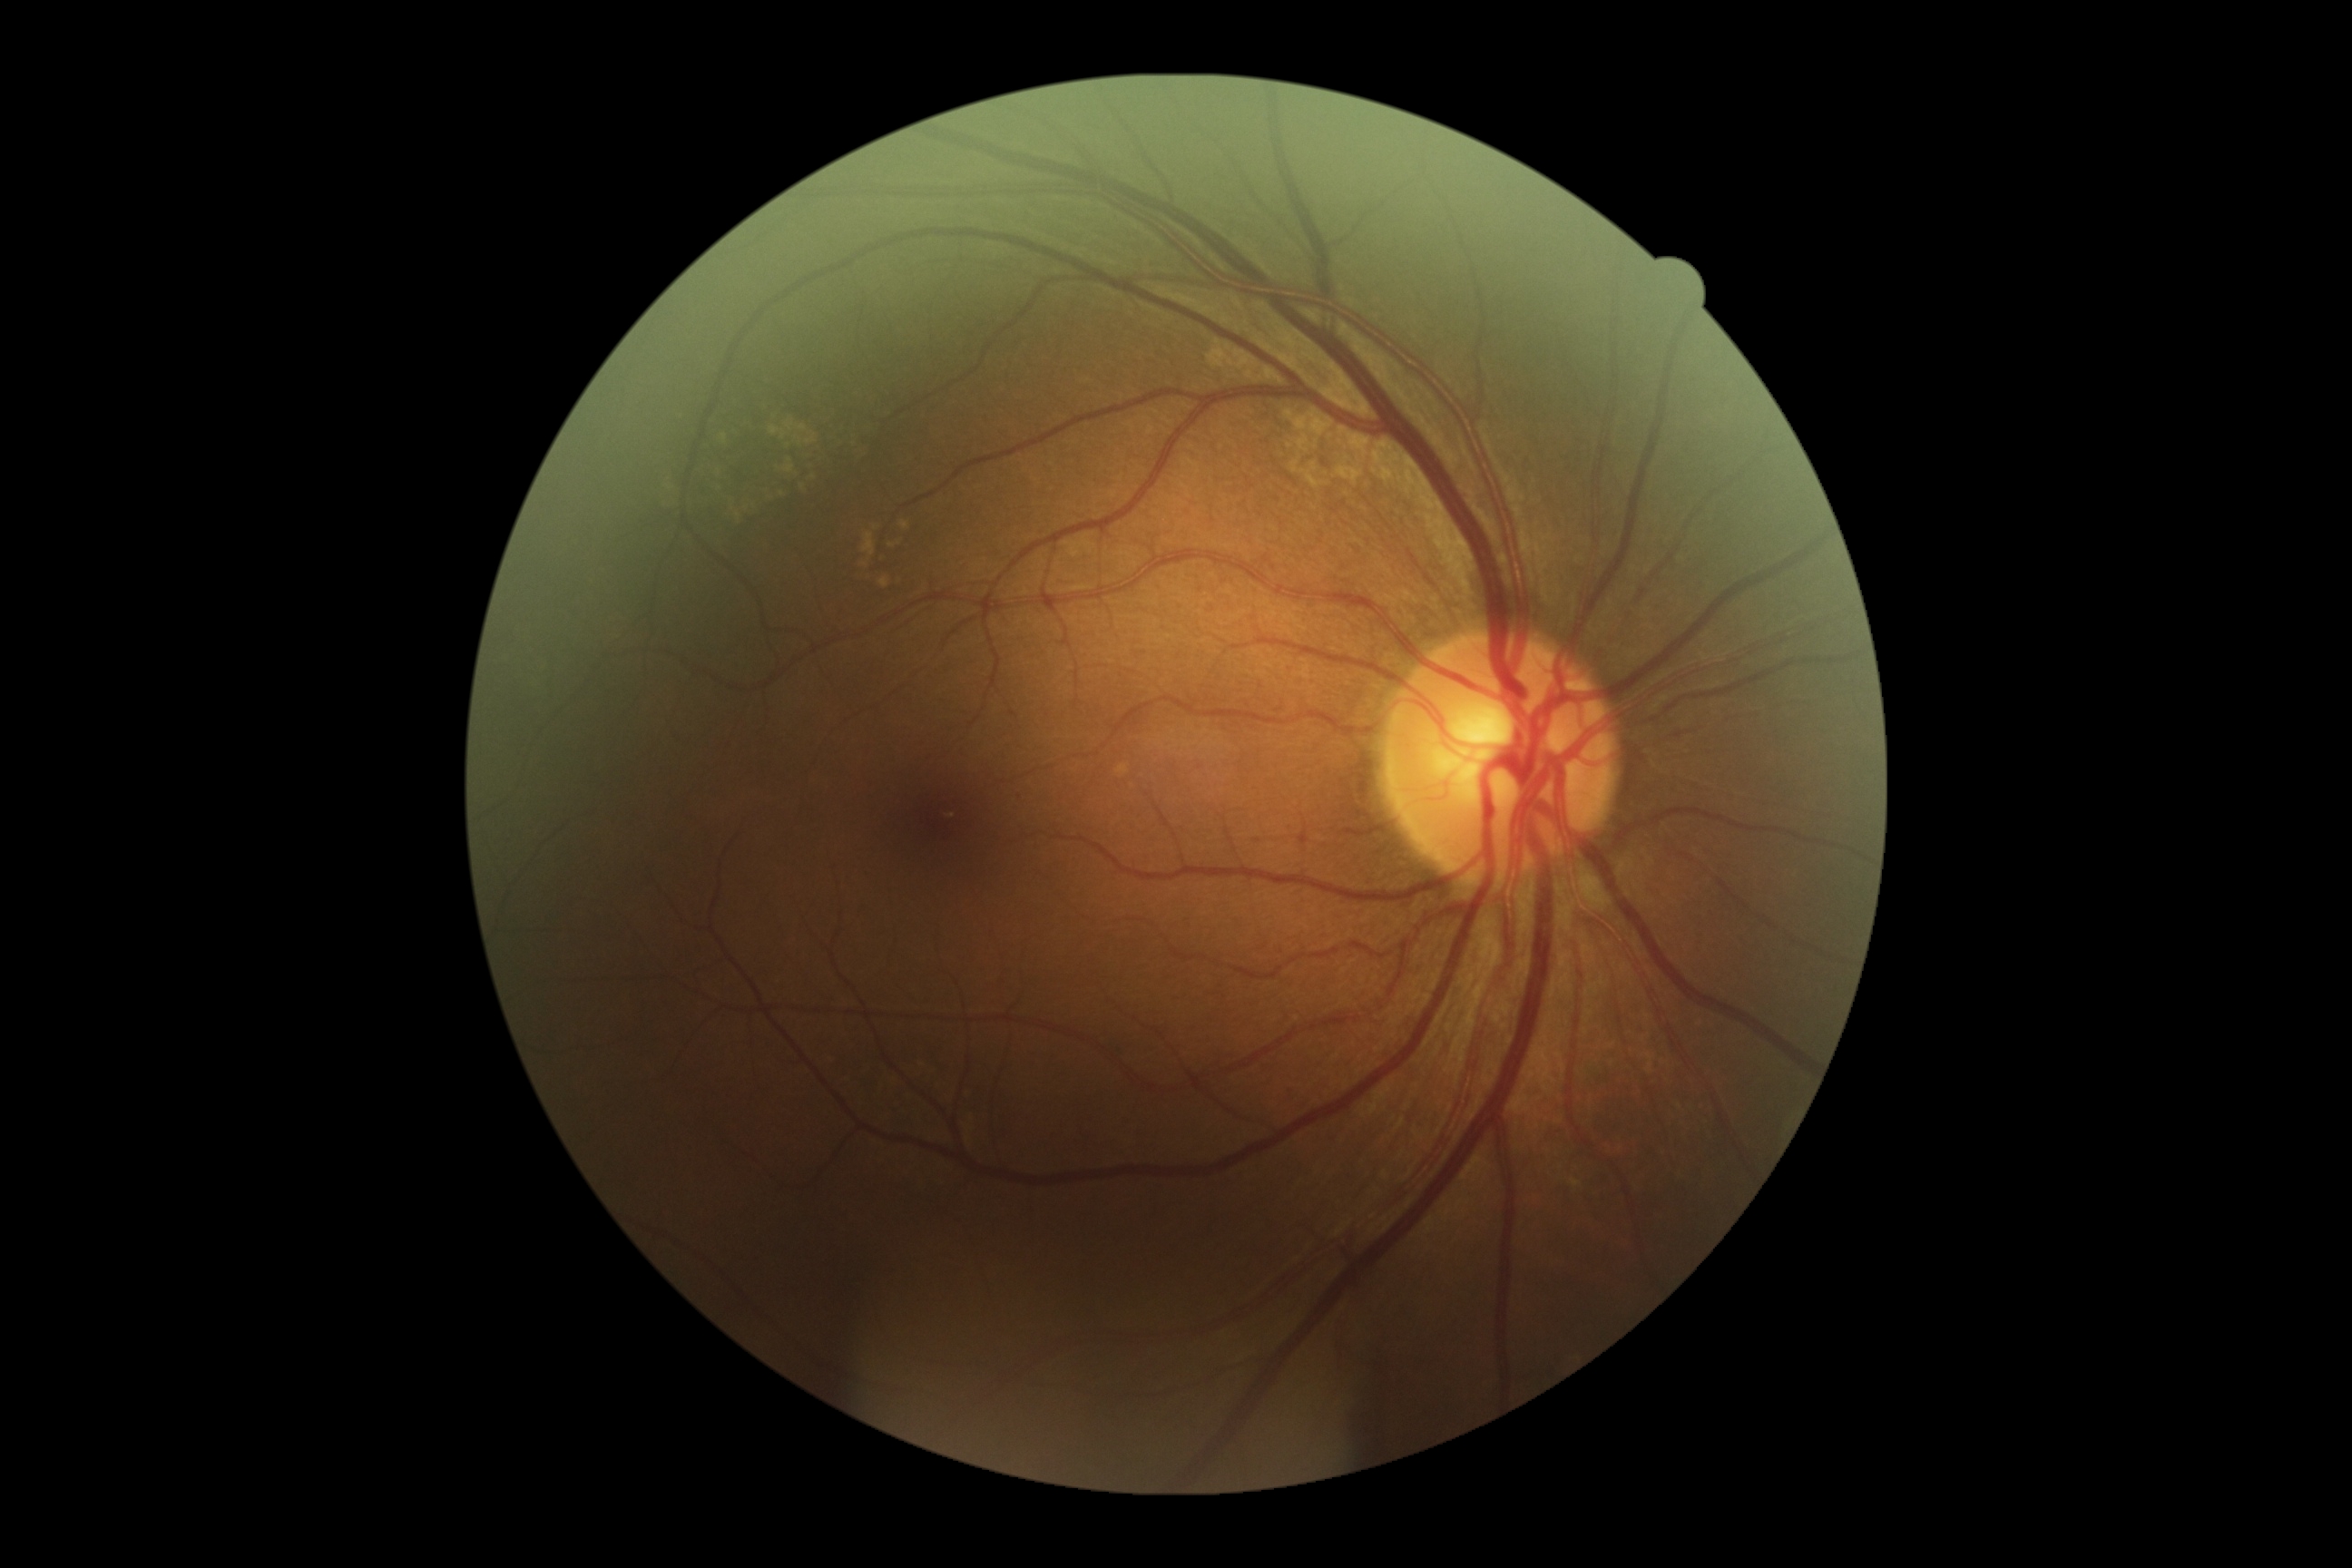
diabetic retinopathy=grade 0 (no apparent retinopathy); DR impression=no apparent DR.